Image size 2184x1682.
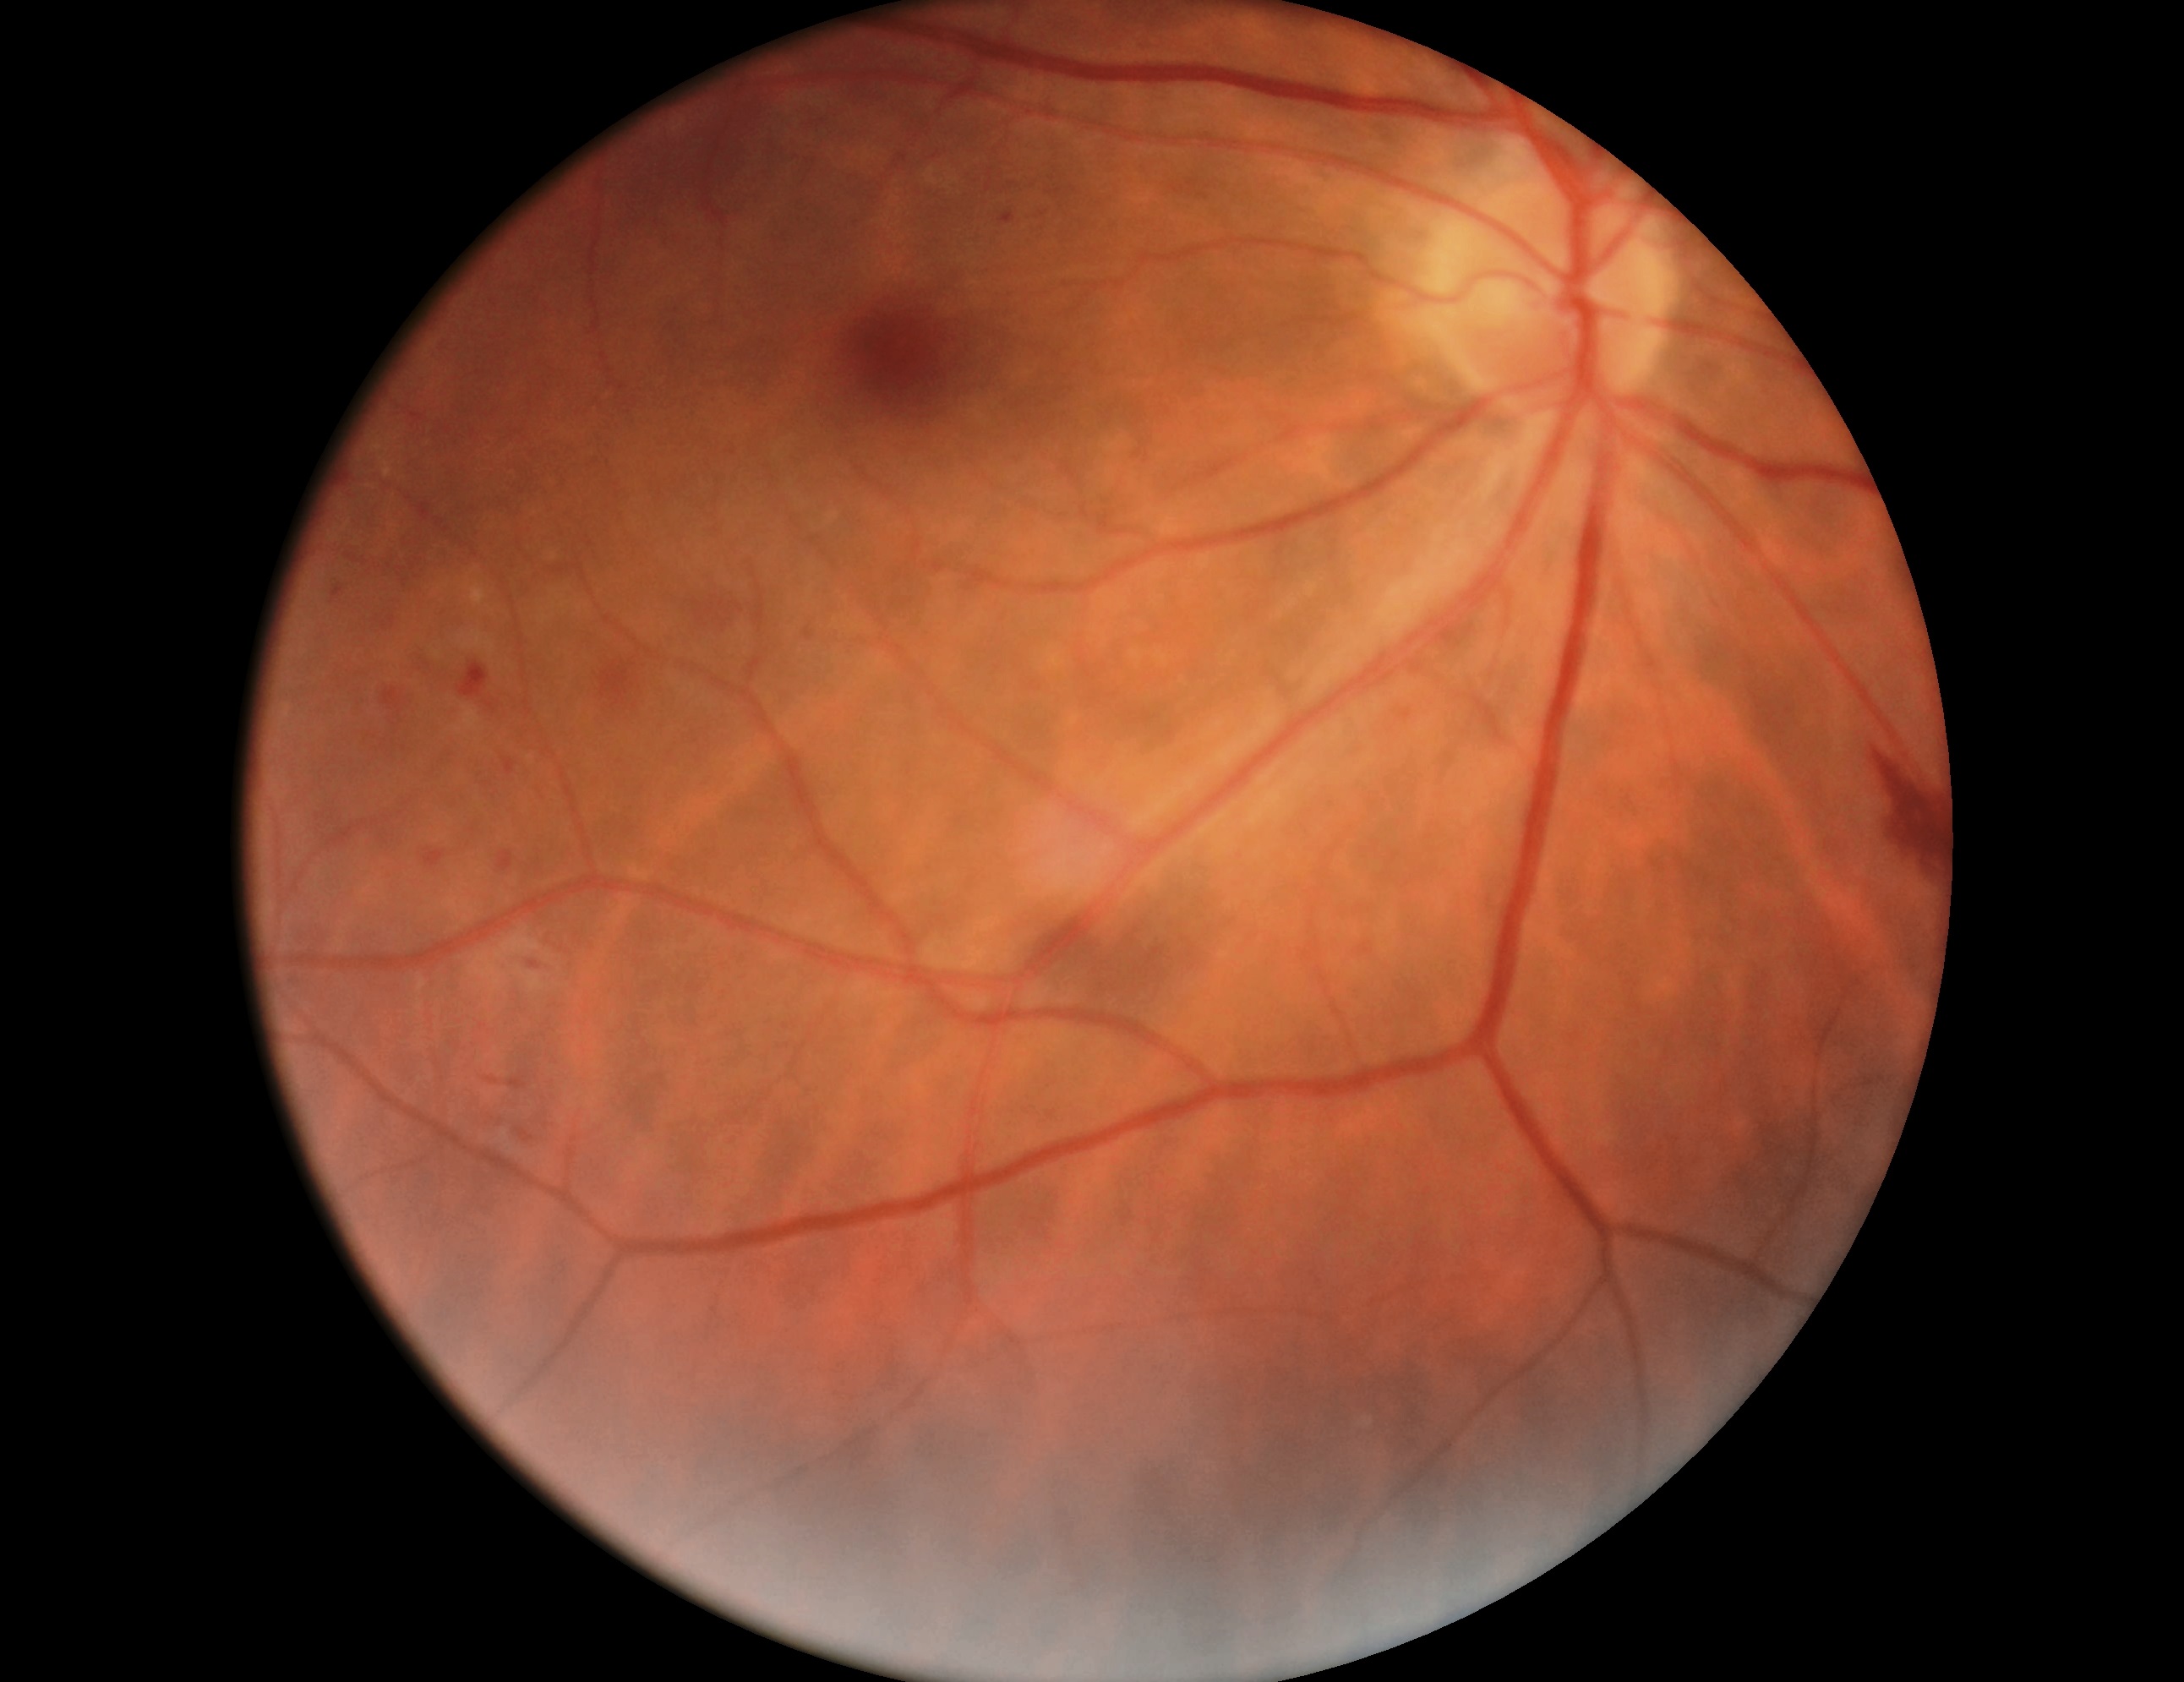 Diabetic retinopathy (DR): 2/4.